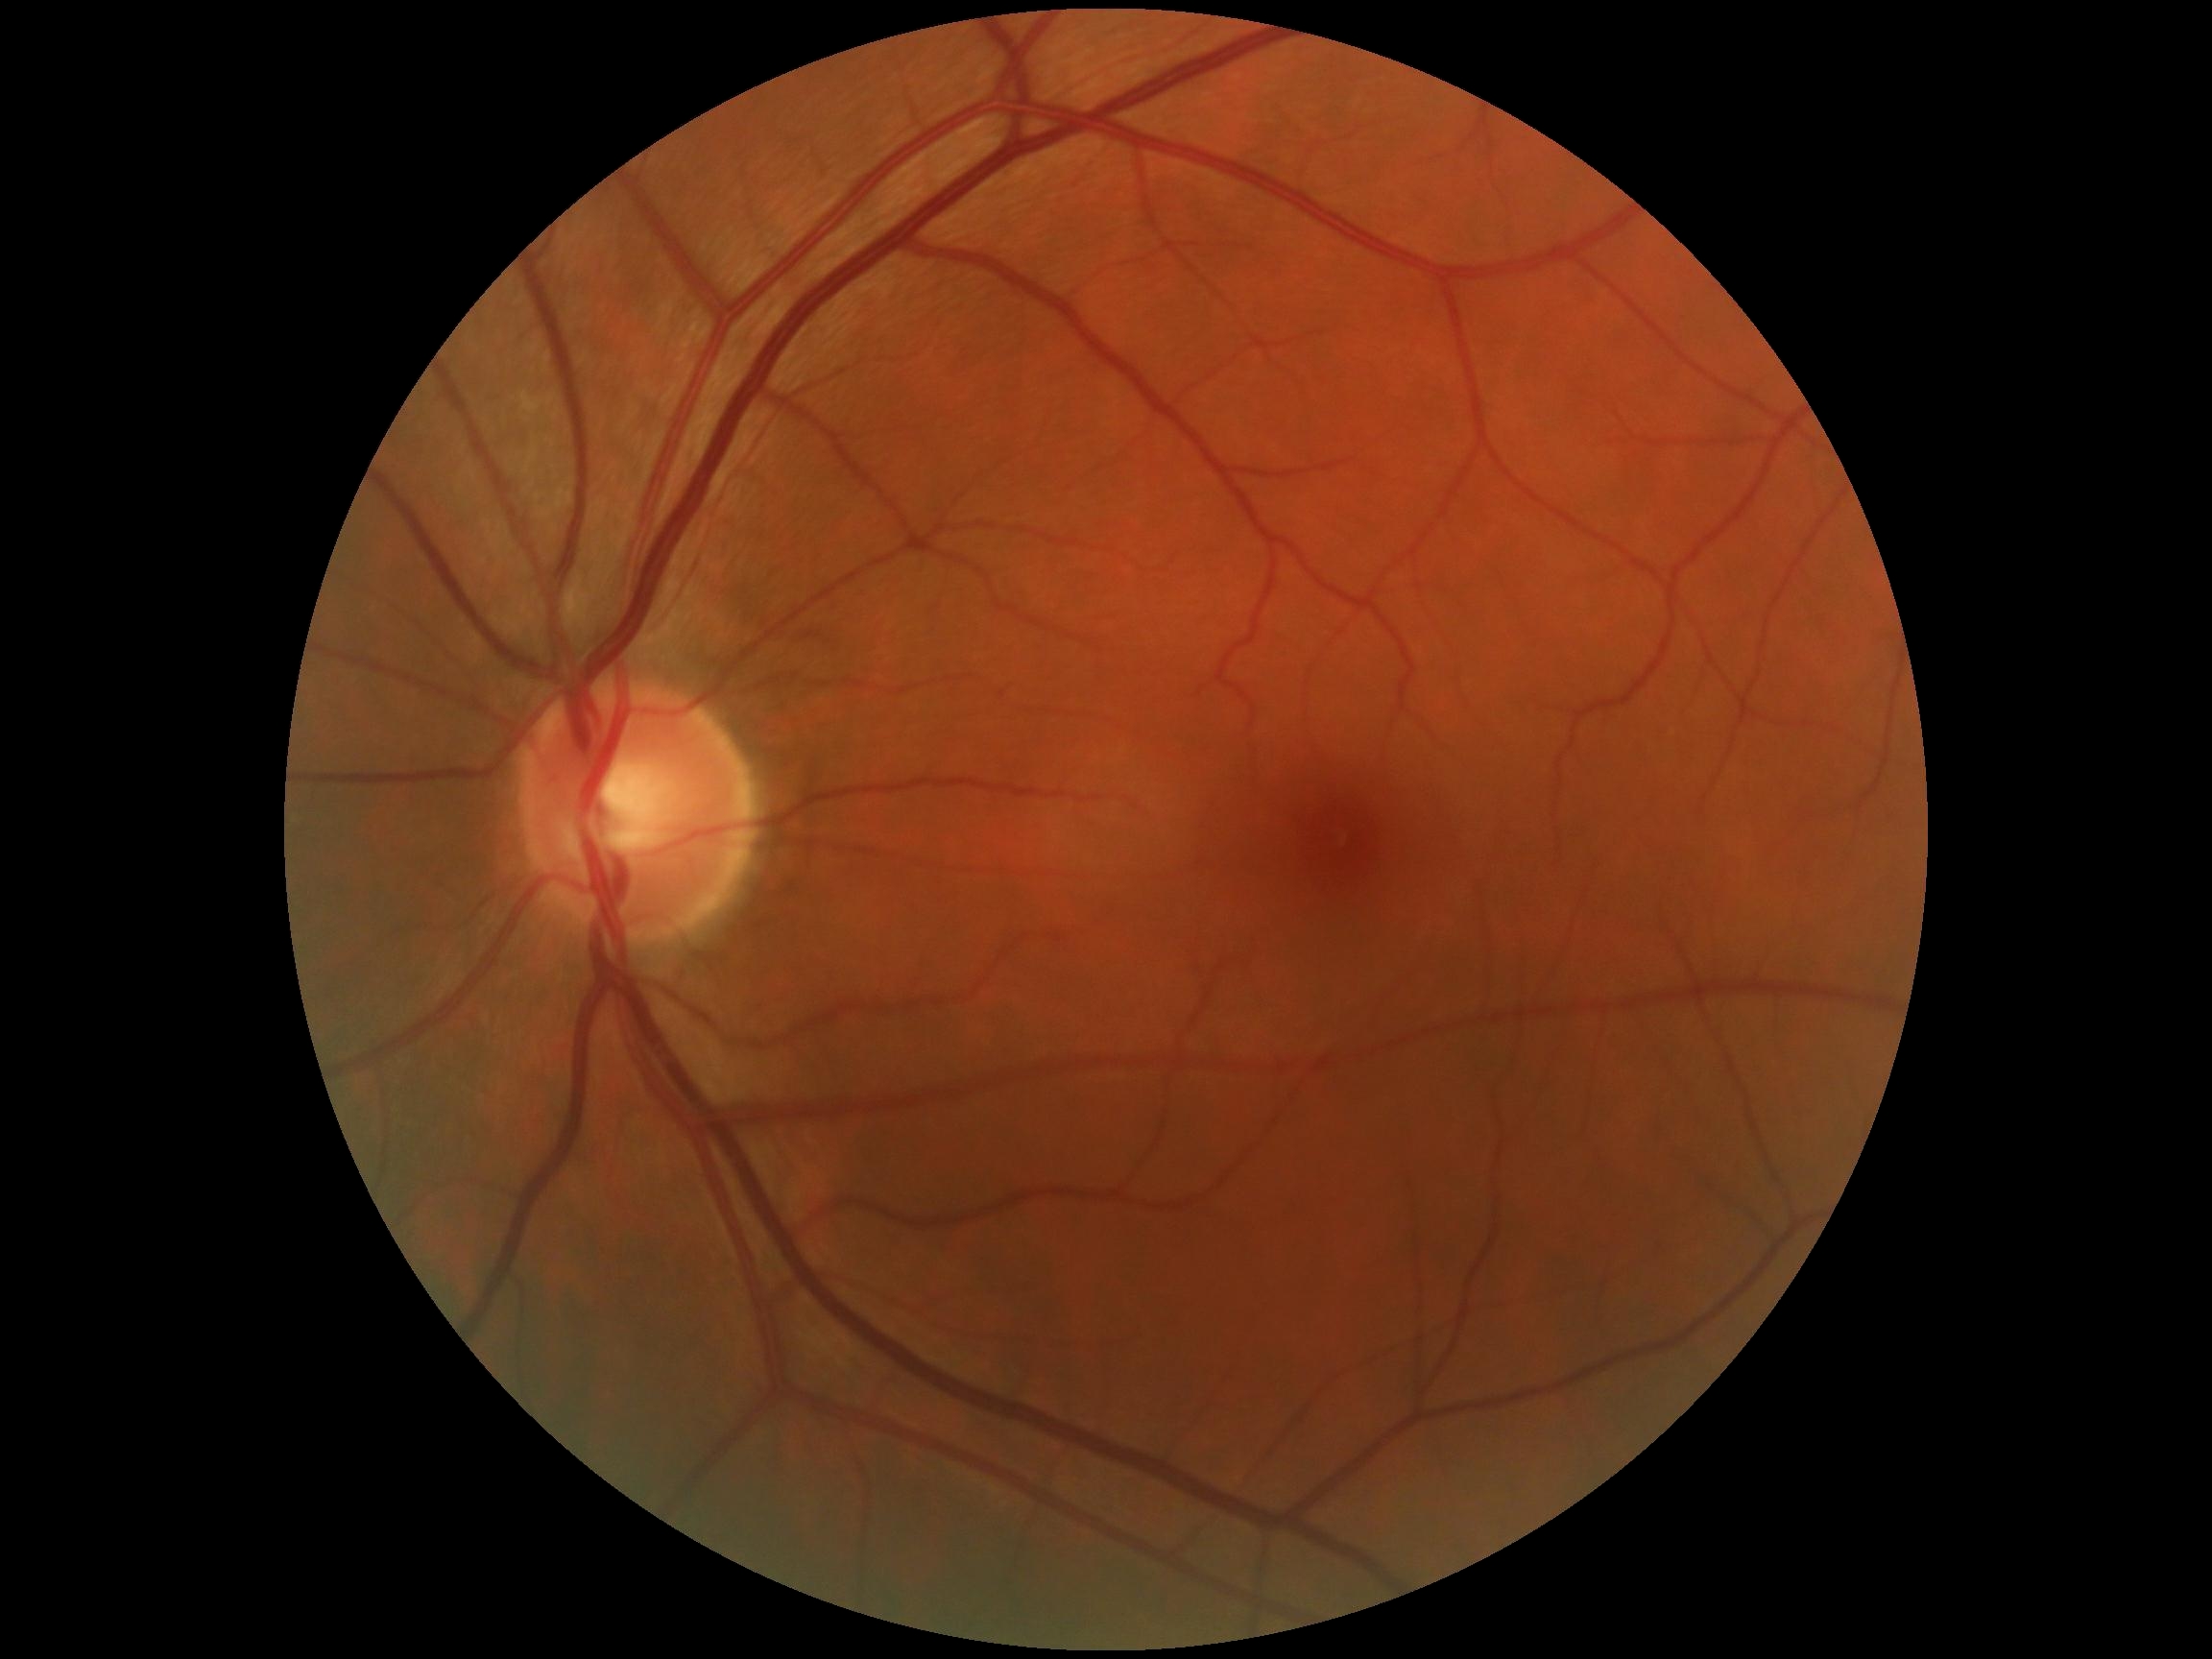 DR grade is no apparent retinopathy (0) — no visible signs of diabetic retinopathy. No DR findings.